1440x1080px. Wide-field fundus photograph of an infant
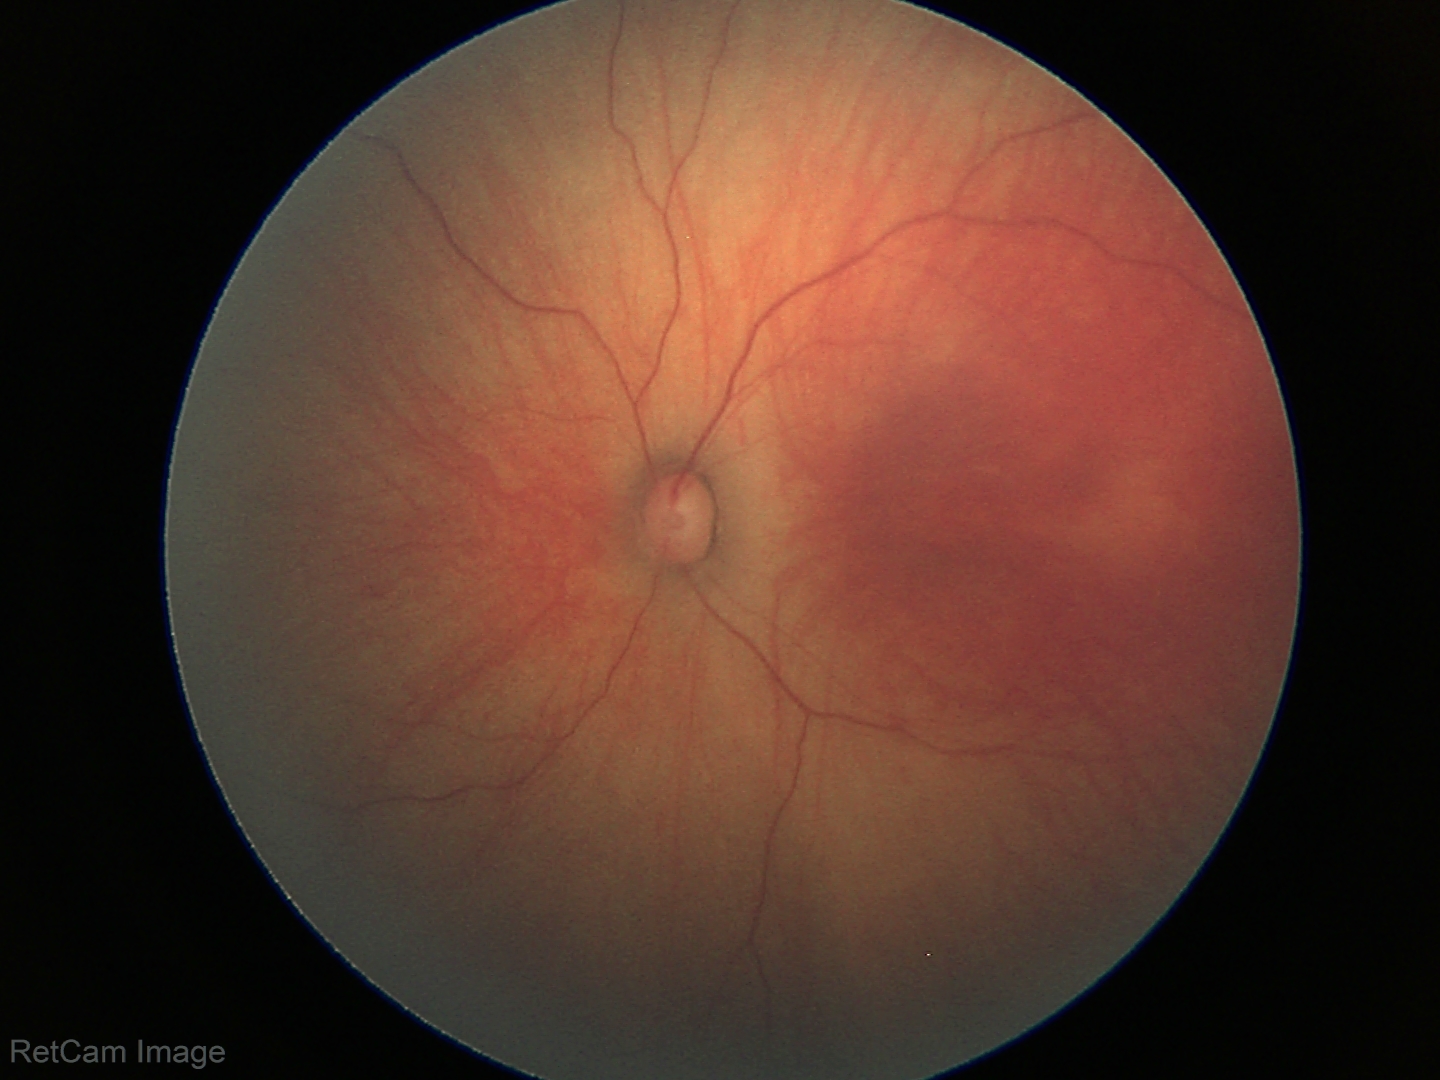
Examination with physiological retinal findings.